Nonmydriatic fundus photograph; image size 848x848; DR severity per modified Davis staging: 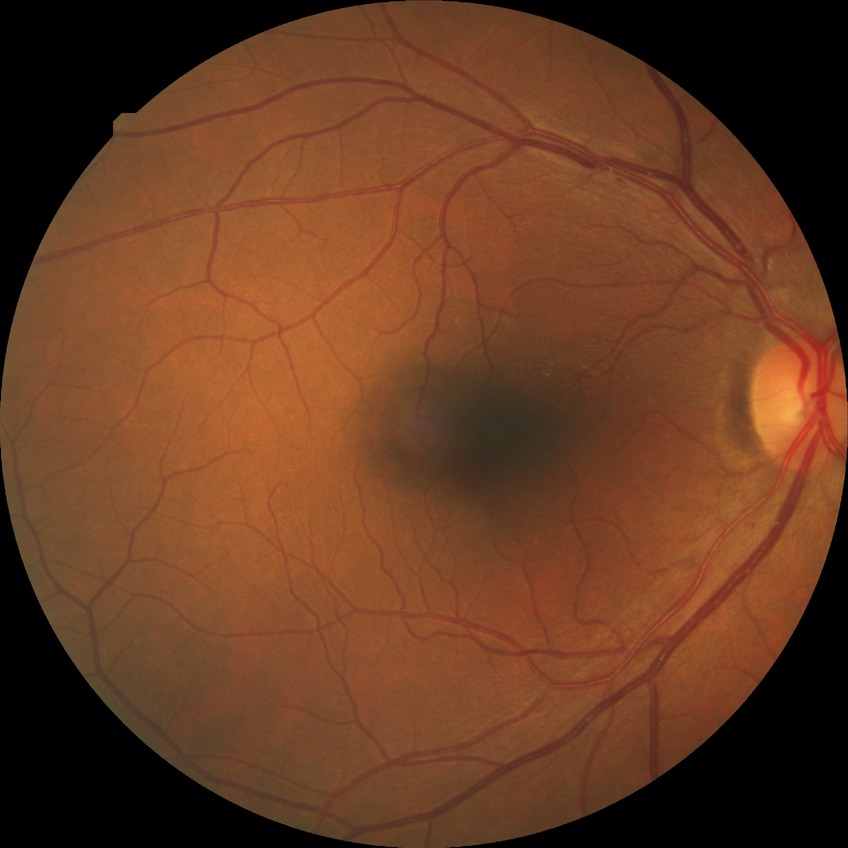
DR is NDR.